CFP:
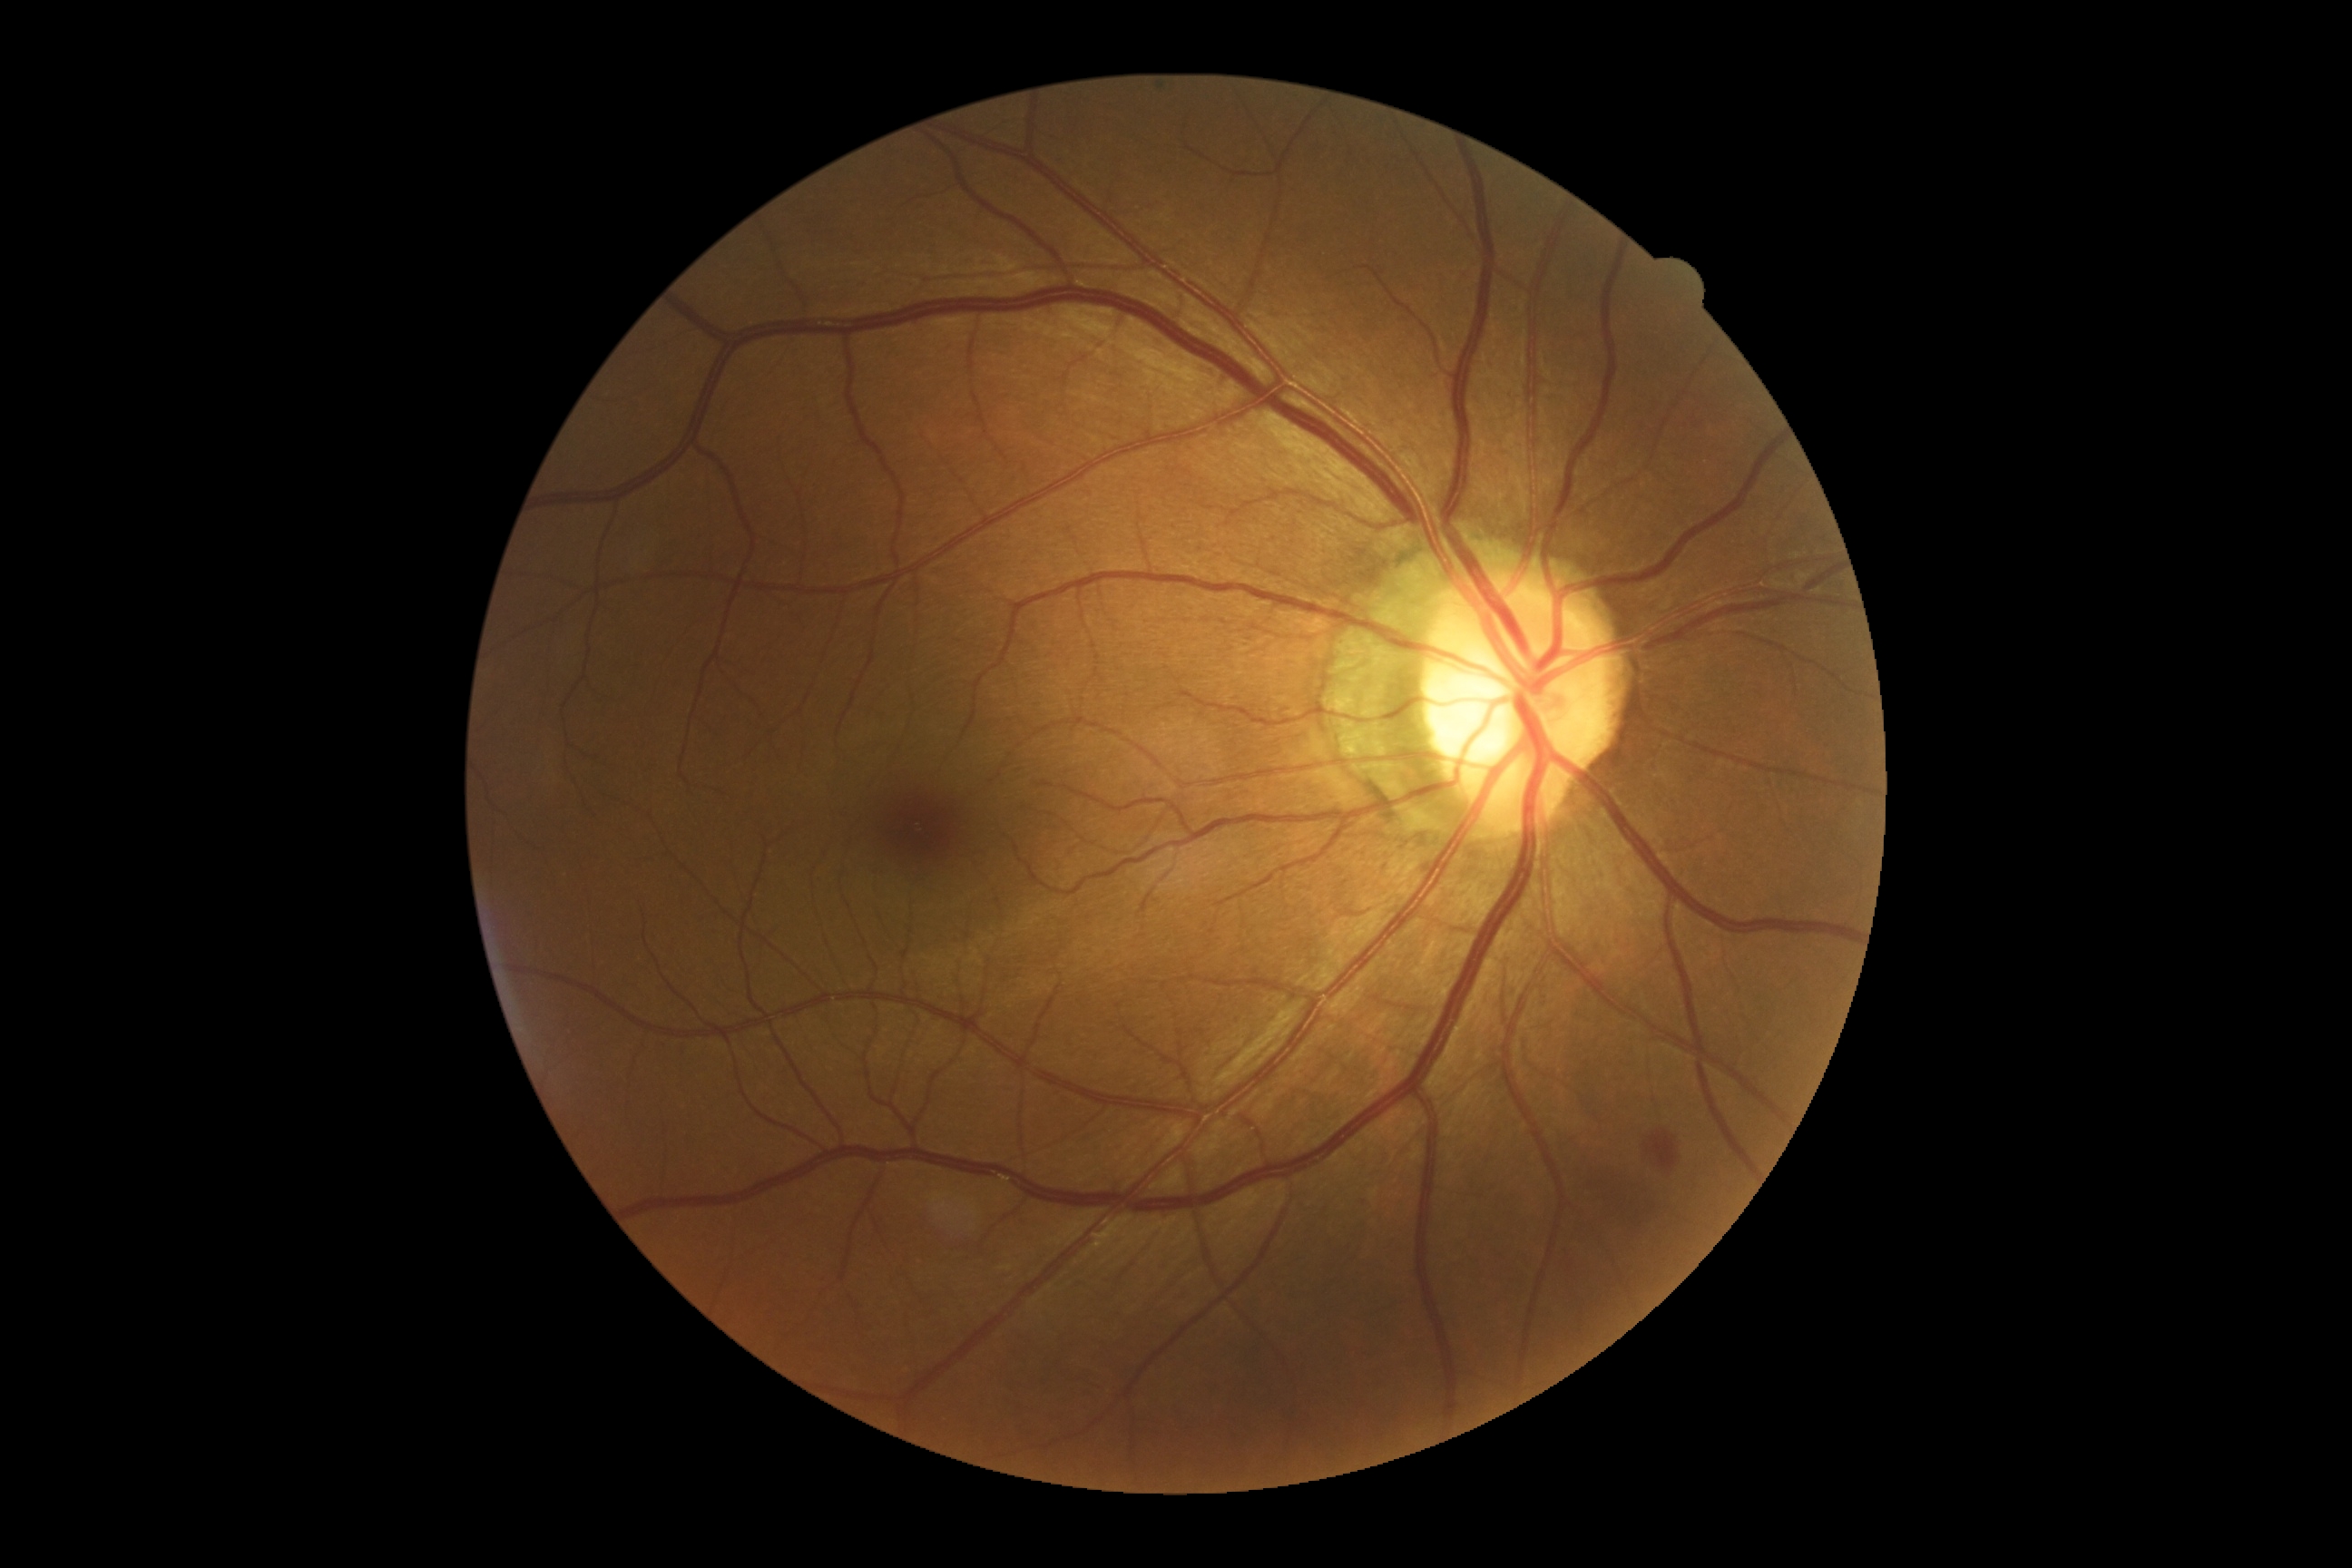

{"dr_grade": "2"}